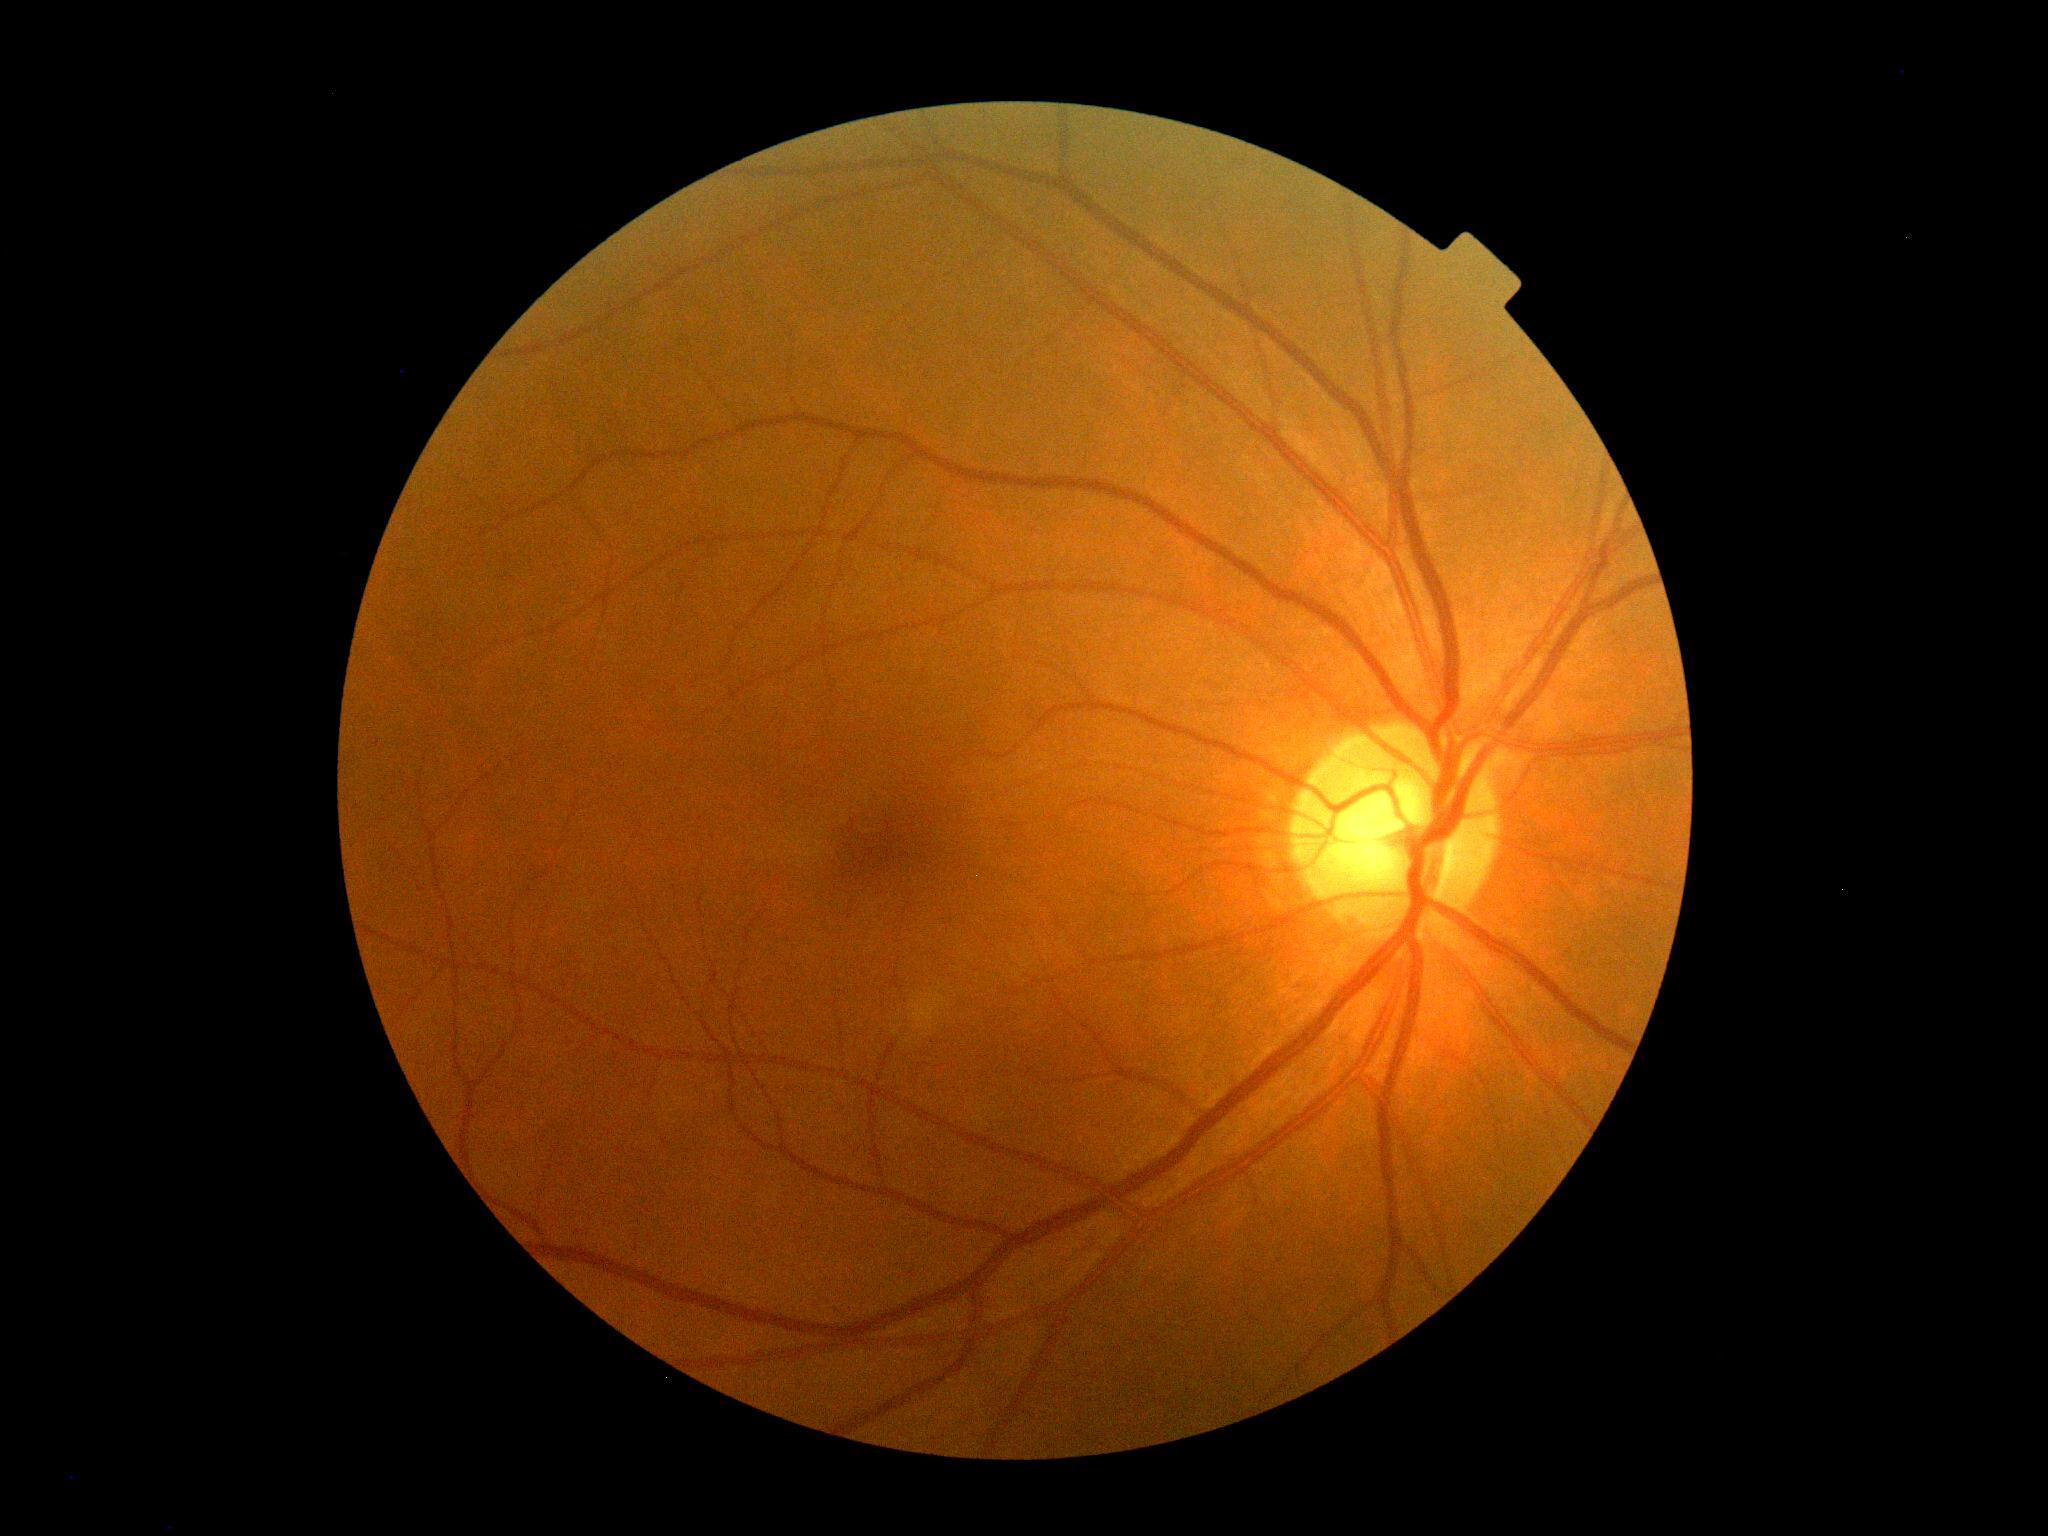

No signs of diabetic retinopathy. Diabetic retinopathy (DR) is 0/4.